Phoenix ICON wide-field infant fundus image.
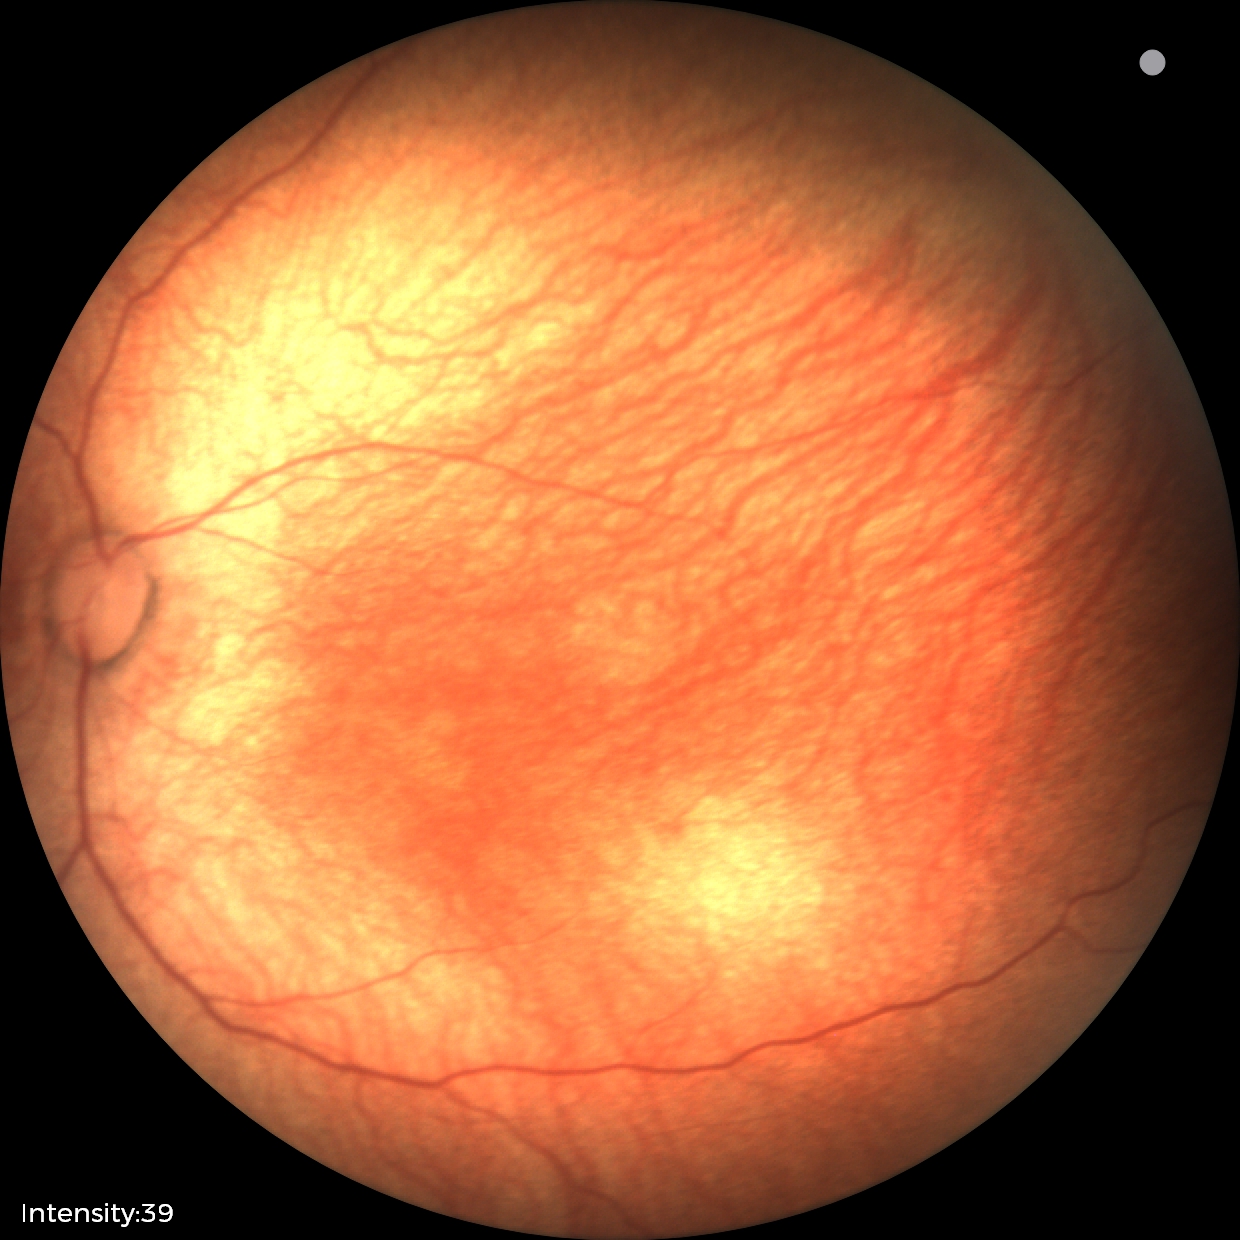
Screening examination diagnosed as physiological.